Posterior pole view; mydriatic (tropicamide and phenylephrine)
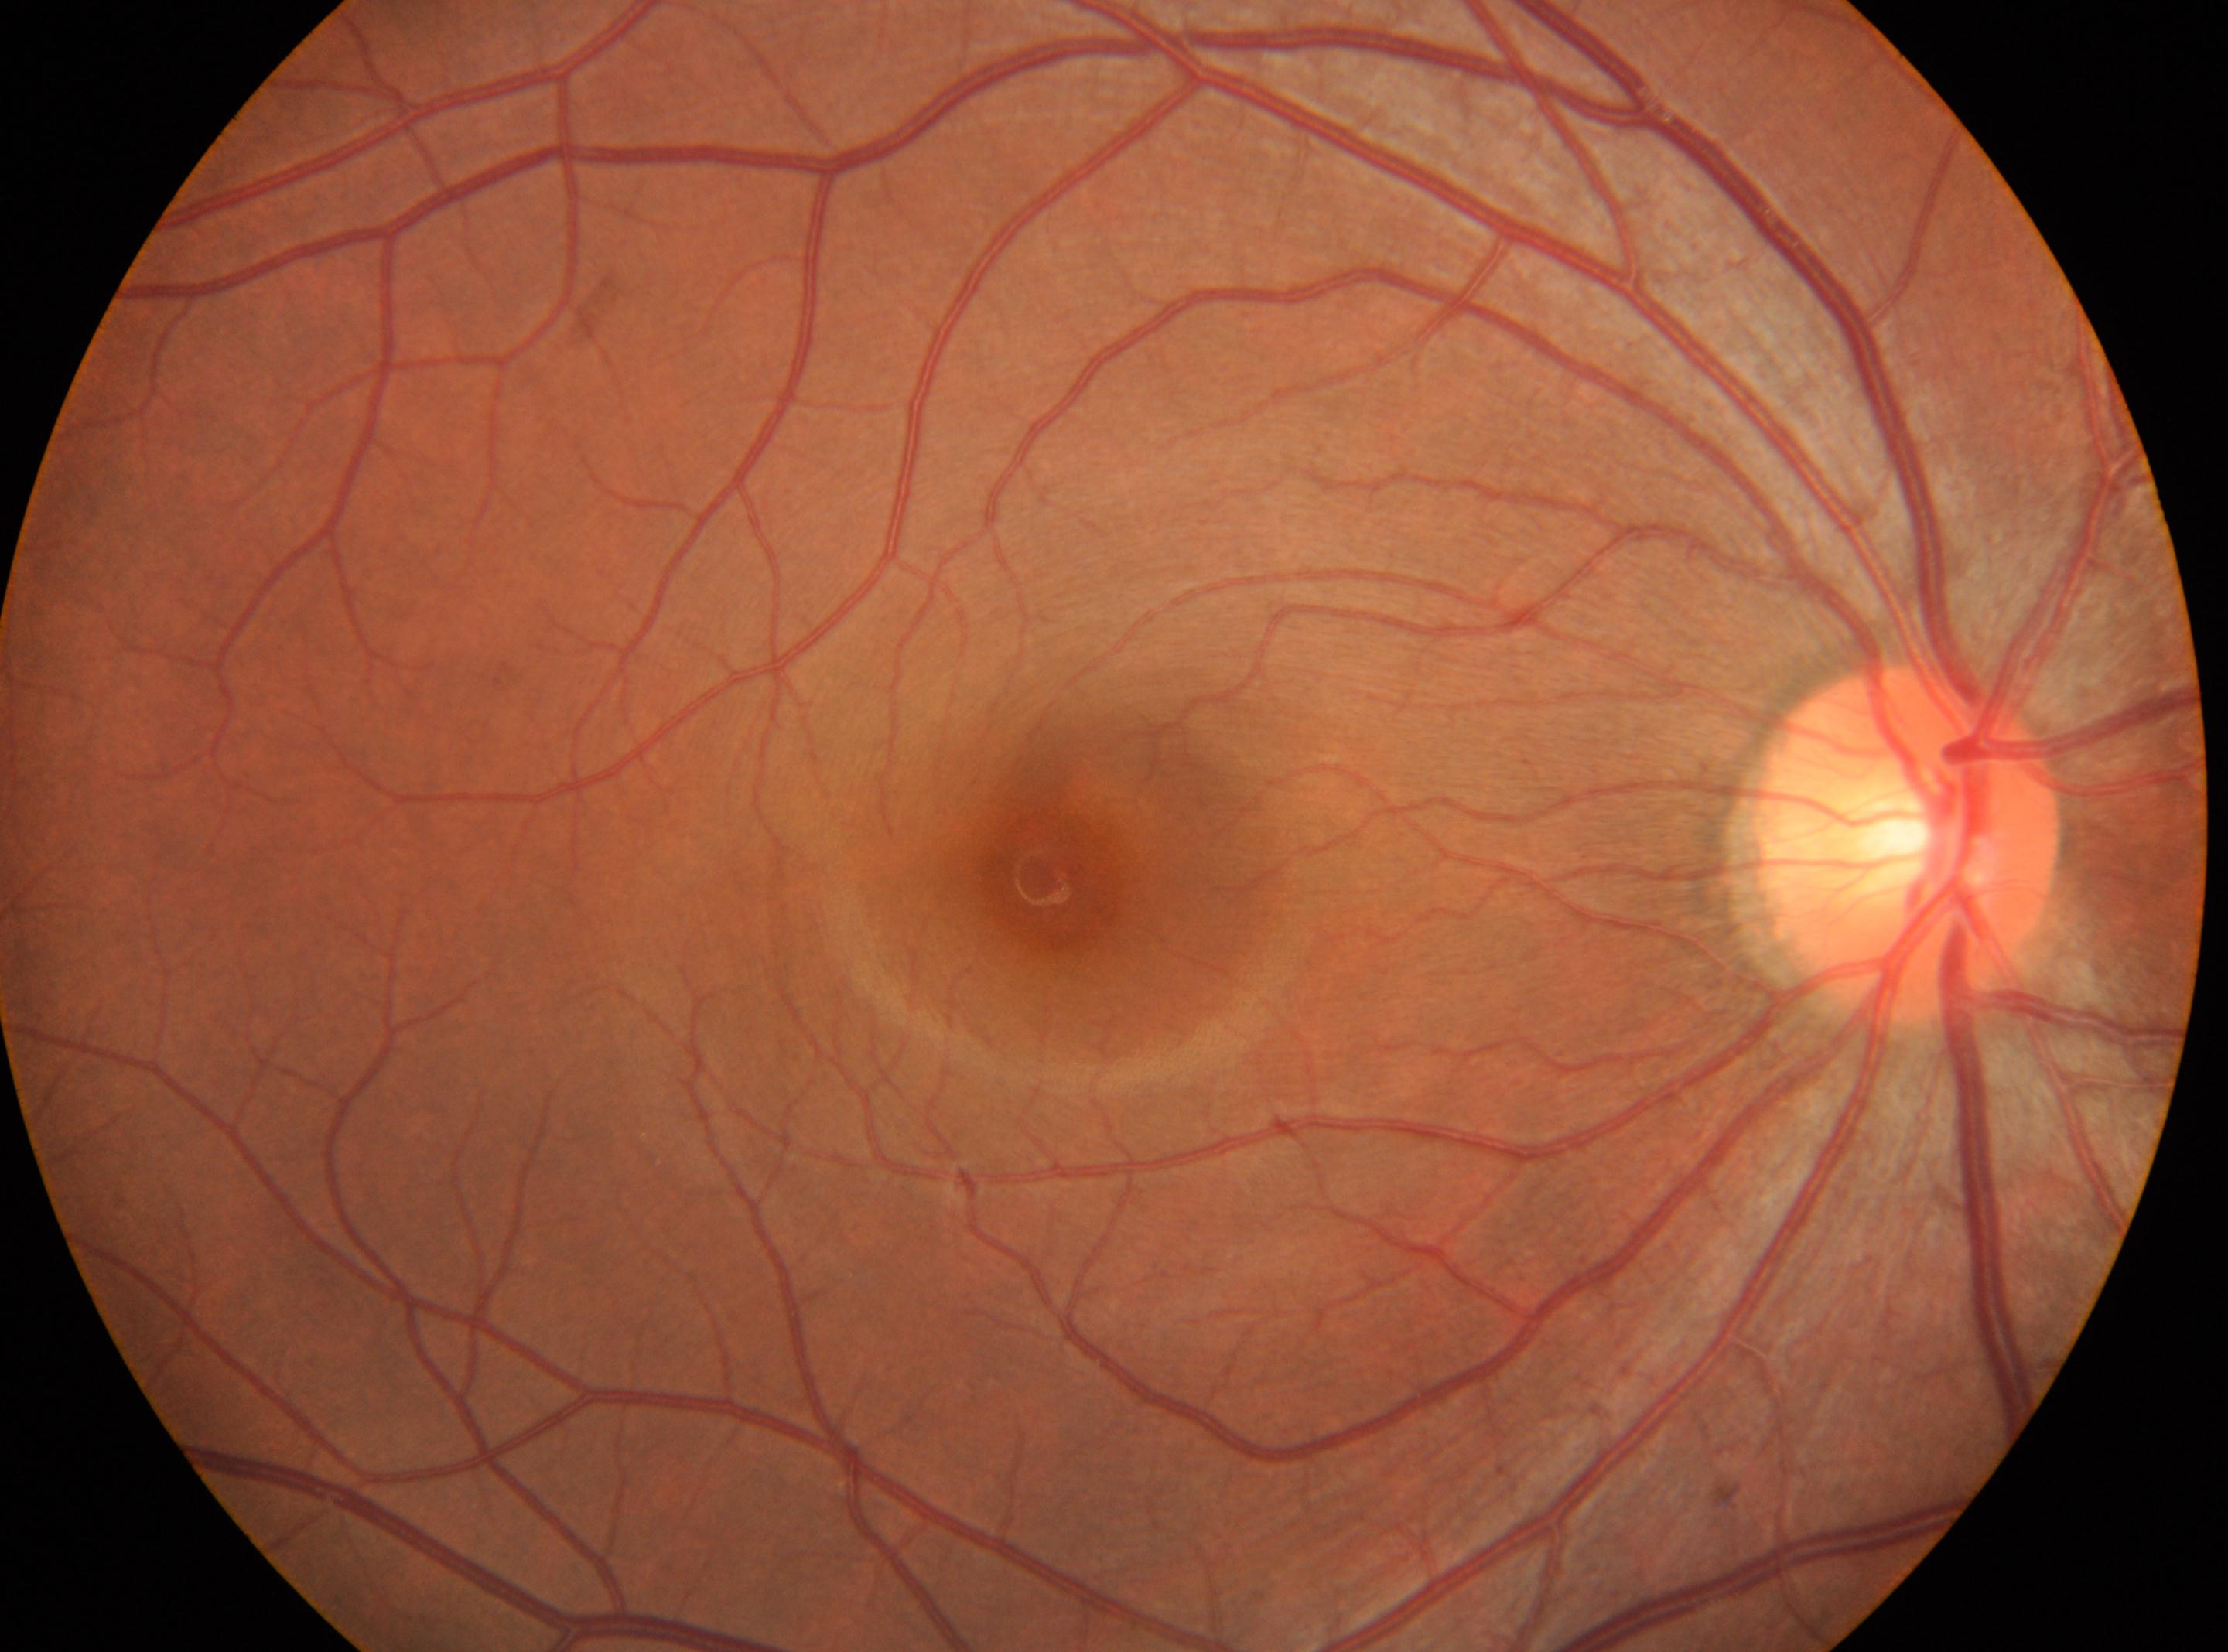 ONH: (x: 1908, y: 846).
Diabetic retinopathy (DR): no apparent retinopathy (grade 0) — no visible signs of diabetic retinopathy.
Fovea located at (x: 1058, y: 879).
This is the oculus dexter.